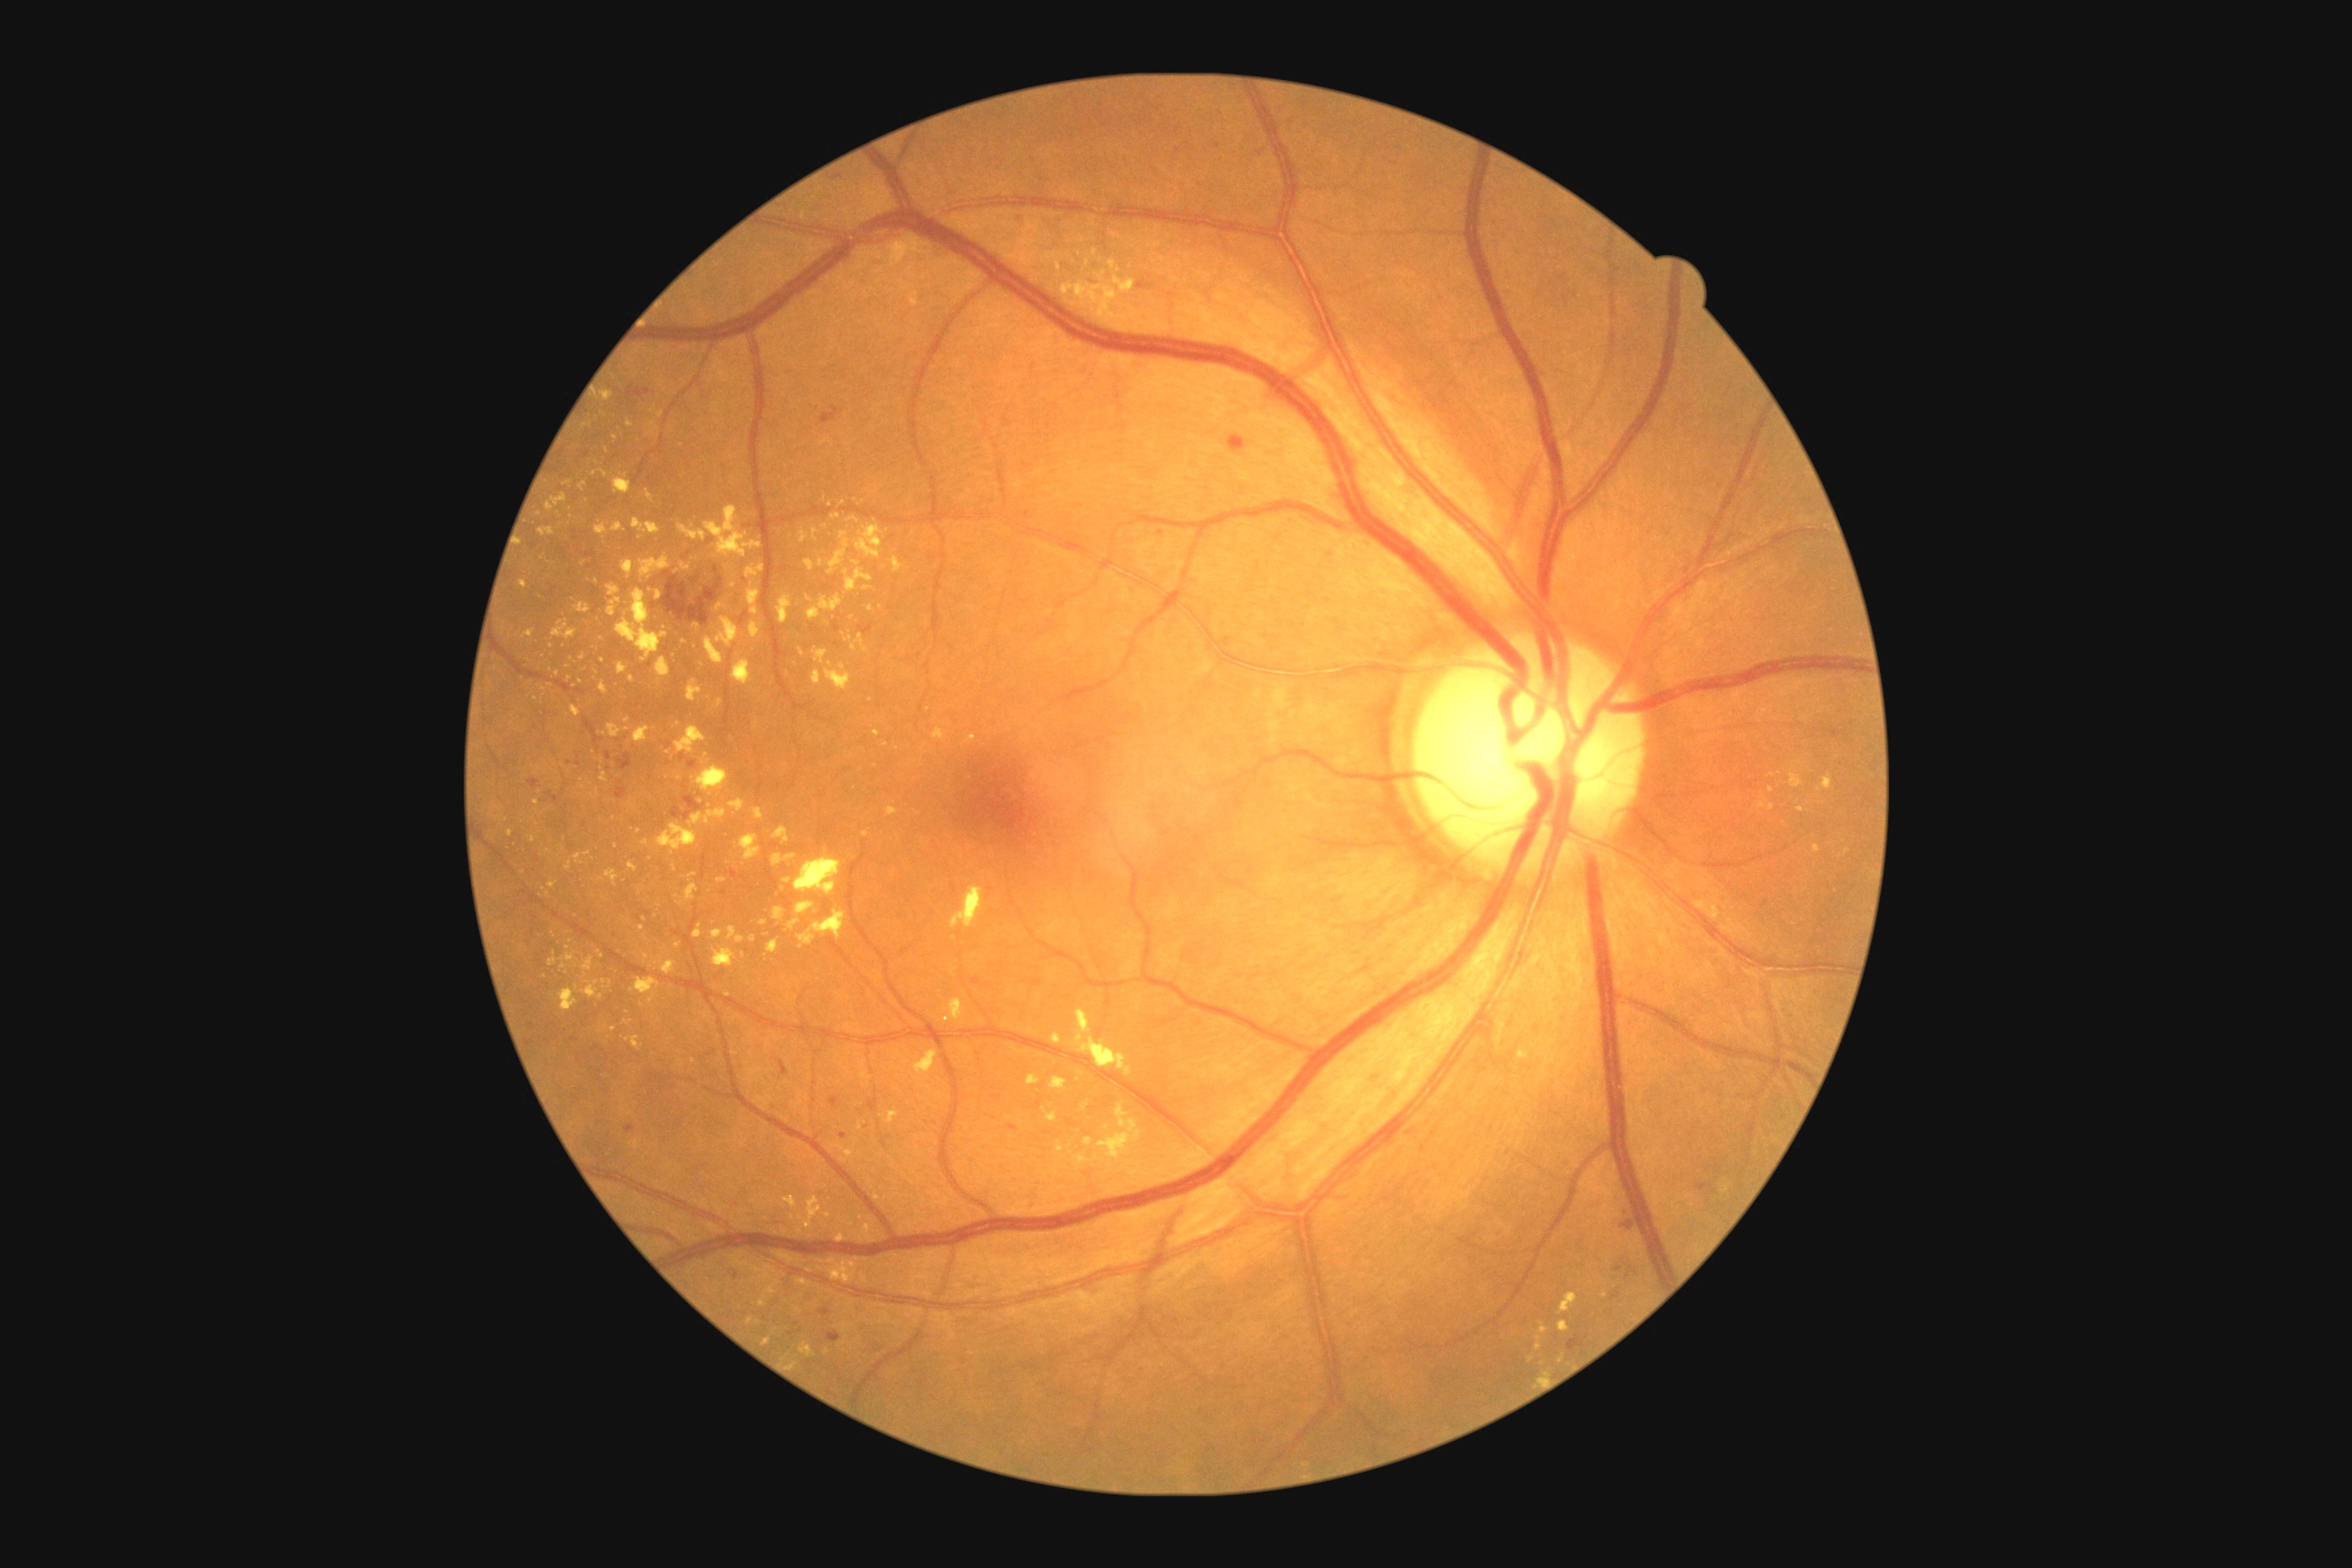
{"partial": true, "dr_grade": 2, "dr_grade_name": "moderate NPDR", "lesions": {"ex": [[645, 491, 654, 502], [848, 518, 859, 524], [1028, 1075, 1041, 1086], [560, 986, 578, 1012], [538, 527, 556, 536], [874, 730, 881, 738], [687, 681, 701, 703], [861, 1273, 868, 1284], [676, 727, 707, 754], [622, 562, 634, 580]], "ex_small_approx": [[628, 730], [661, 961], [554, 935], [628, 1023], [697, 626], [680, 904], [848, 999], [1544, 1329]]}}